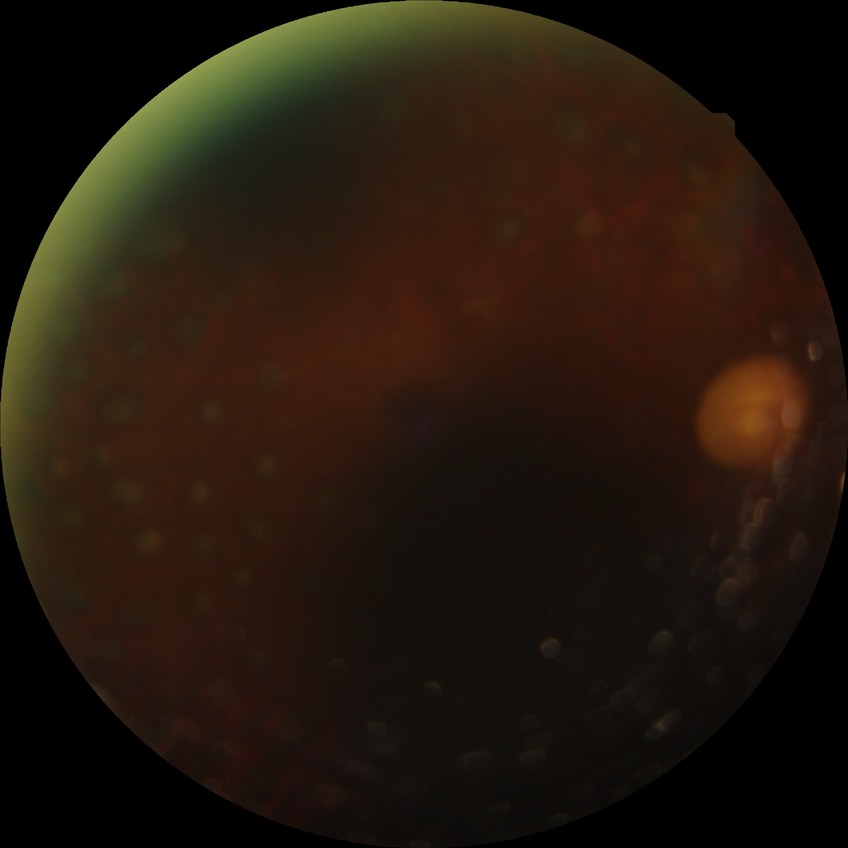

Assessment:
* diabetic retinopathy (DR): proliferative diabetic retinopathy (PDR)